Davis DR grading: 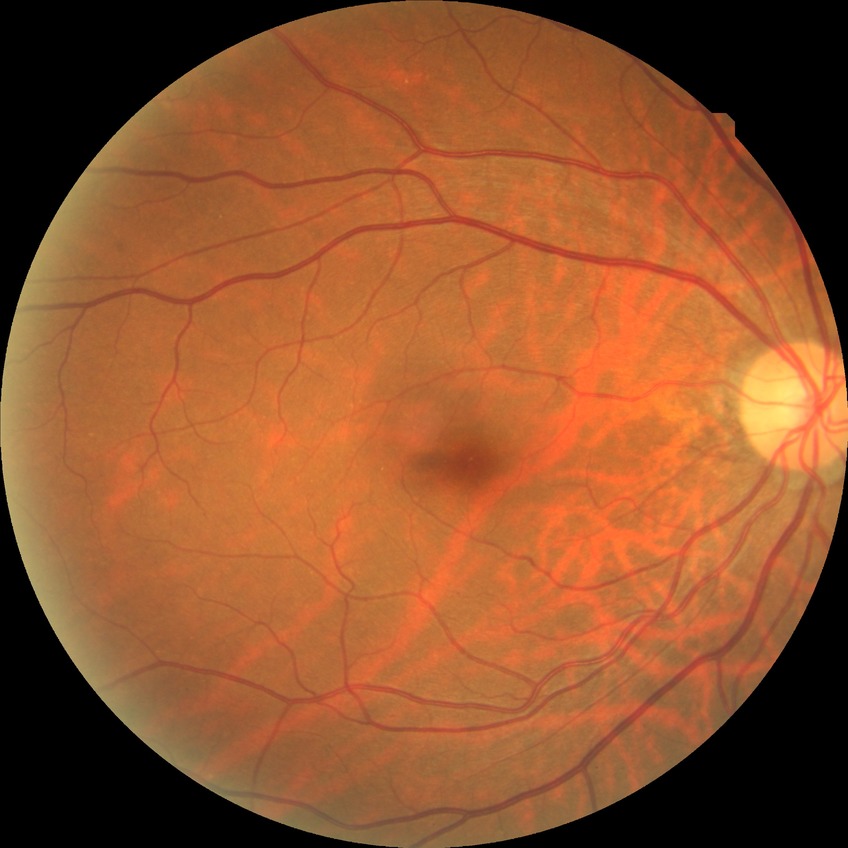
- diabetic retinopathy (DR): NDR (no diabetic retinopathy)